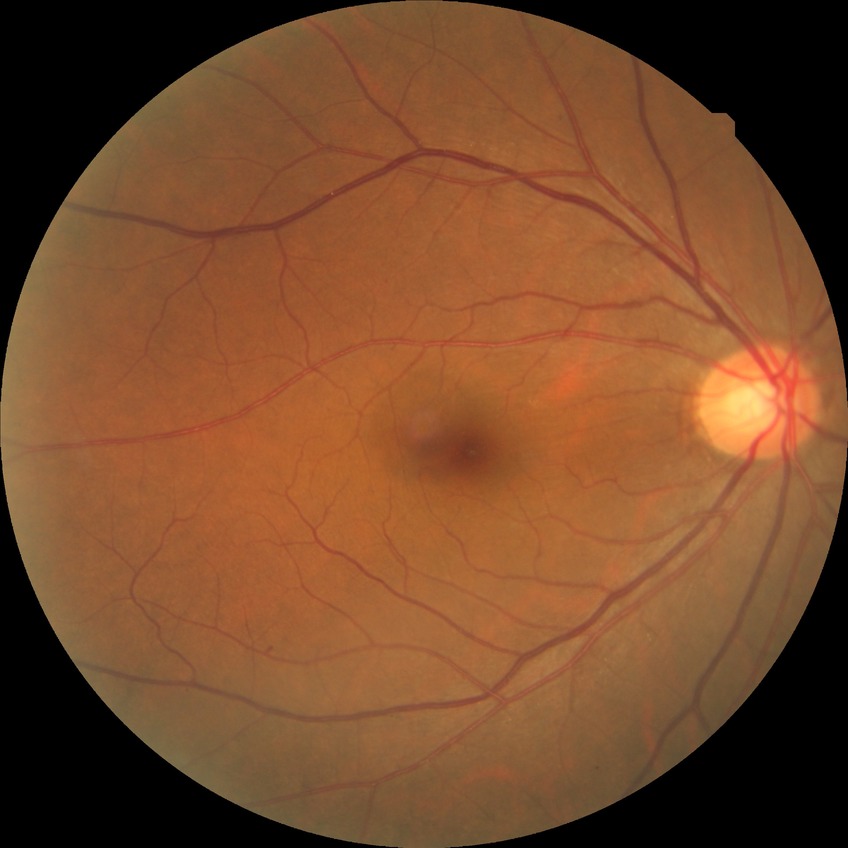

Modified Davis grading is no diabetic retinopathy.